1659 by 2212 pixels
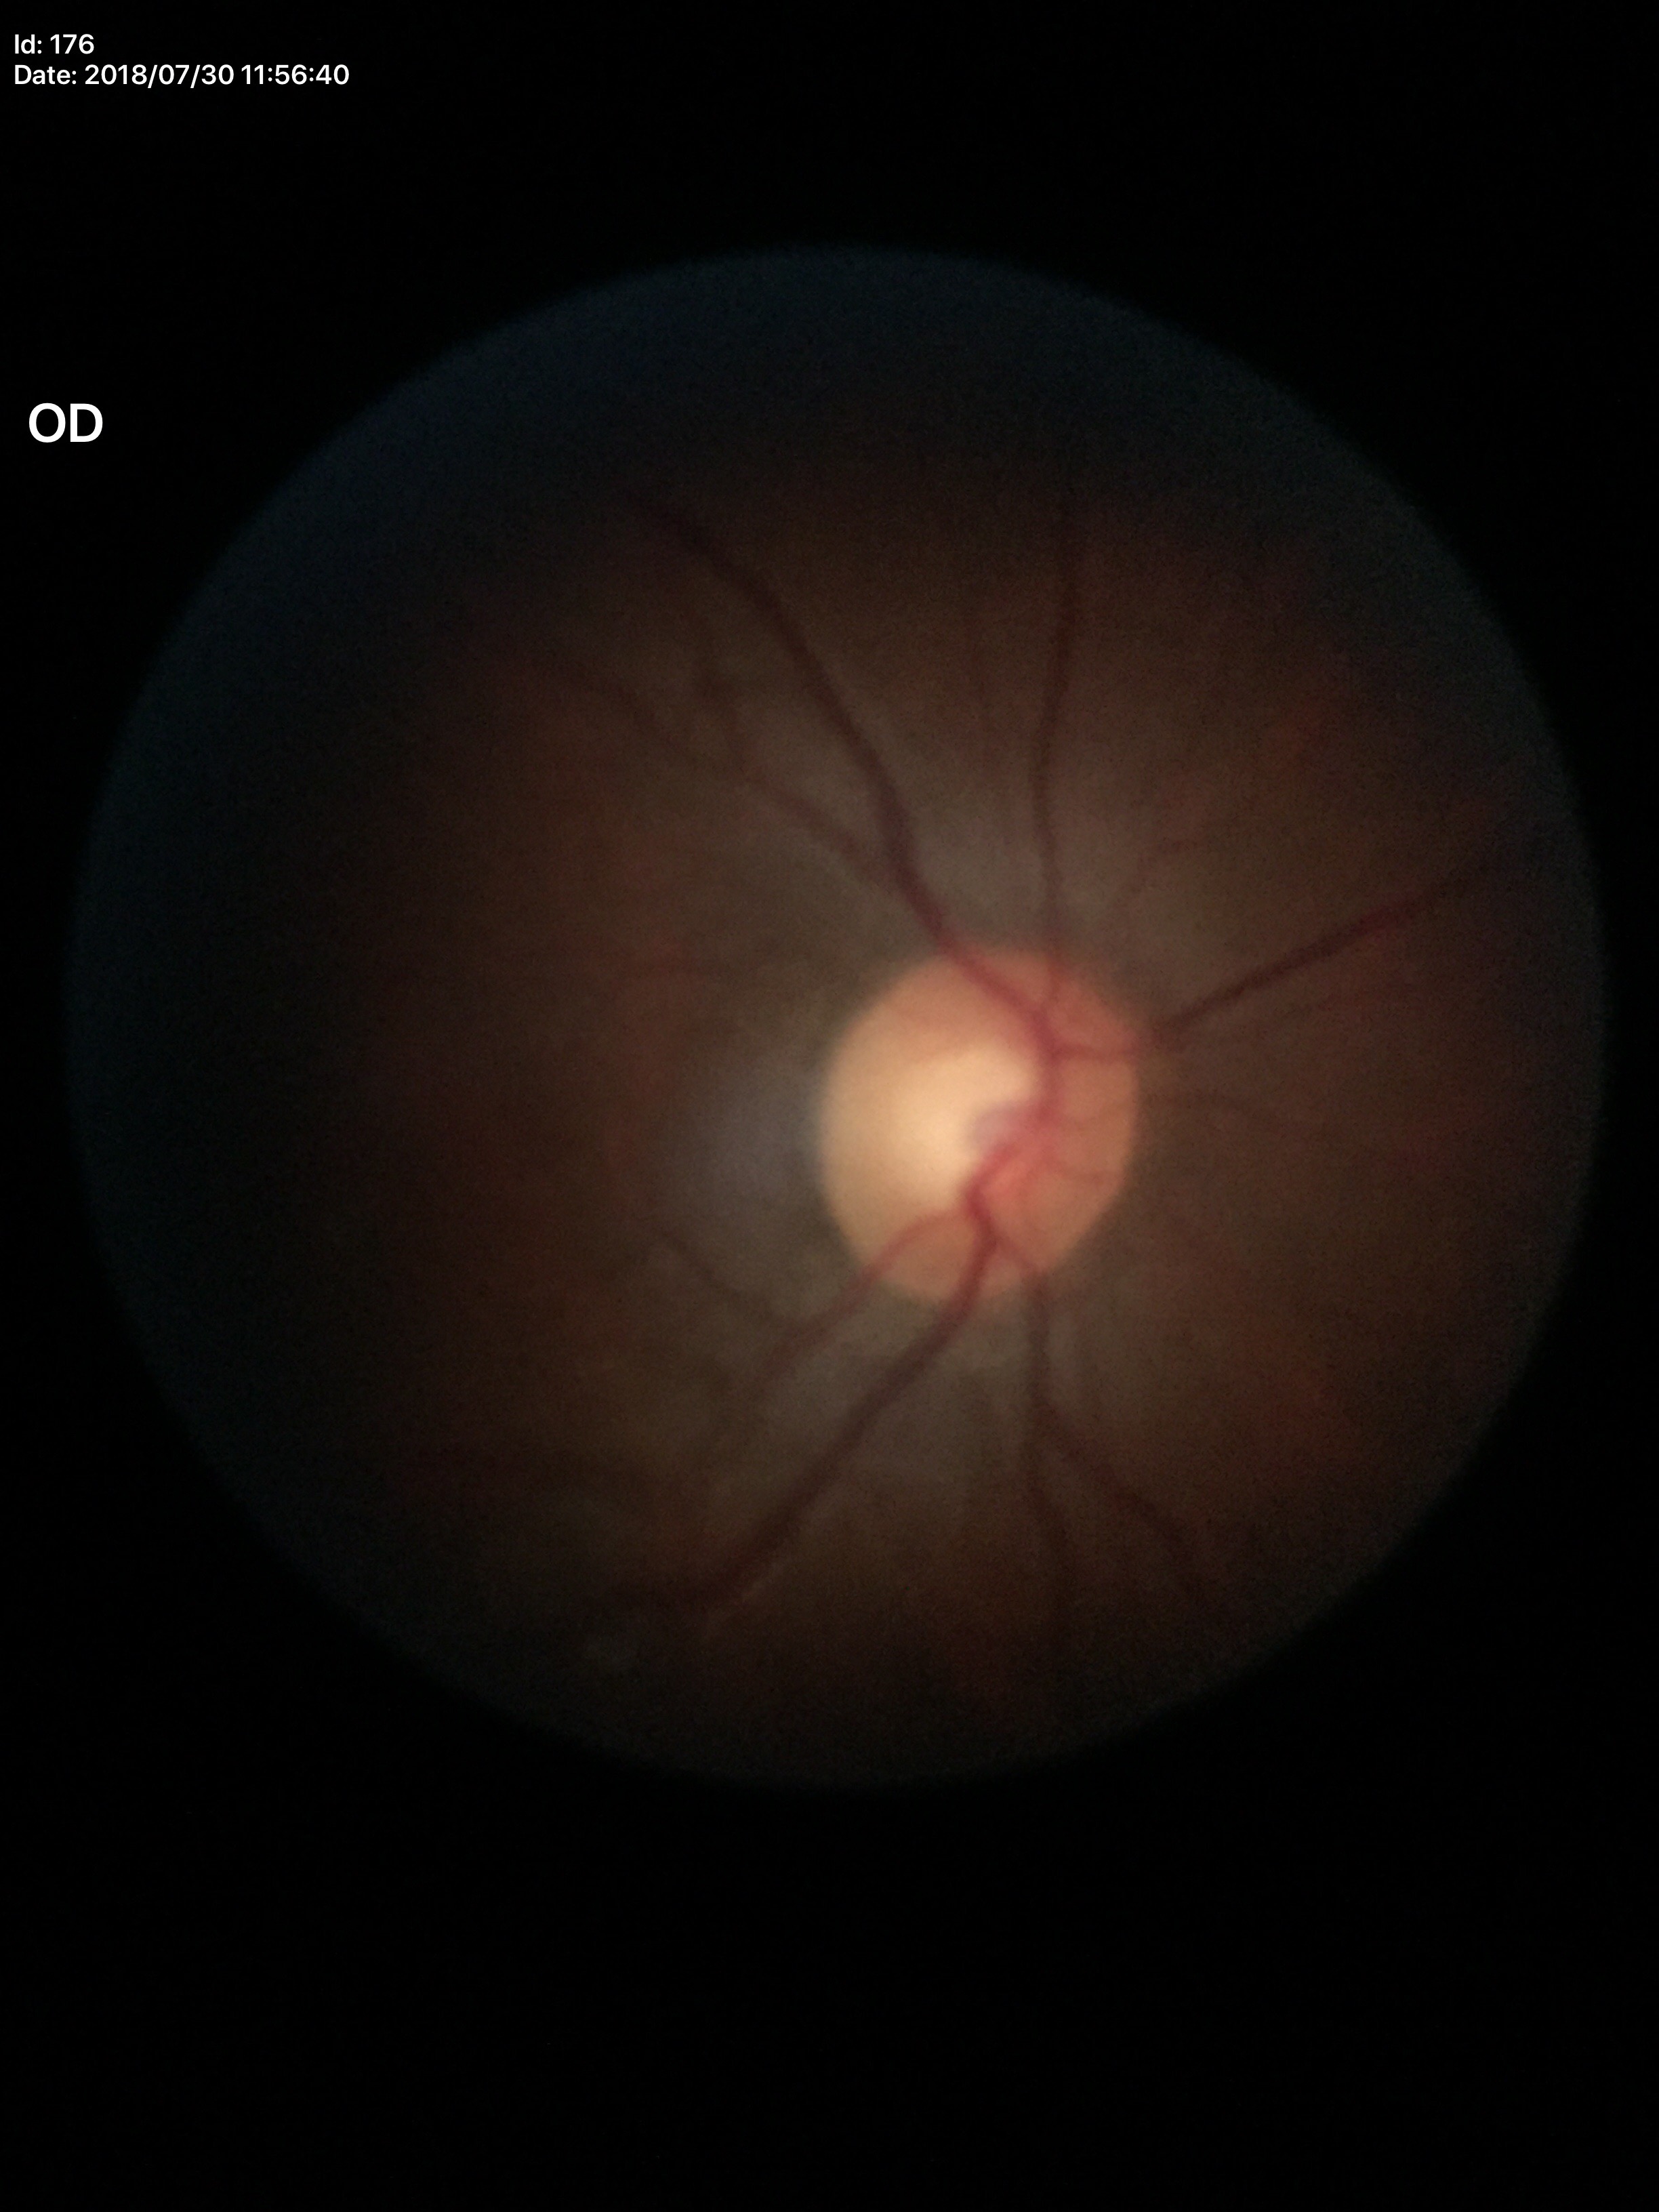 Not suspicious for glaucoma. Vertical C/D ratio (VCDR): 0.54.